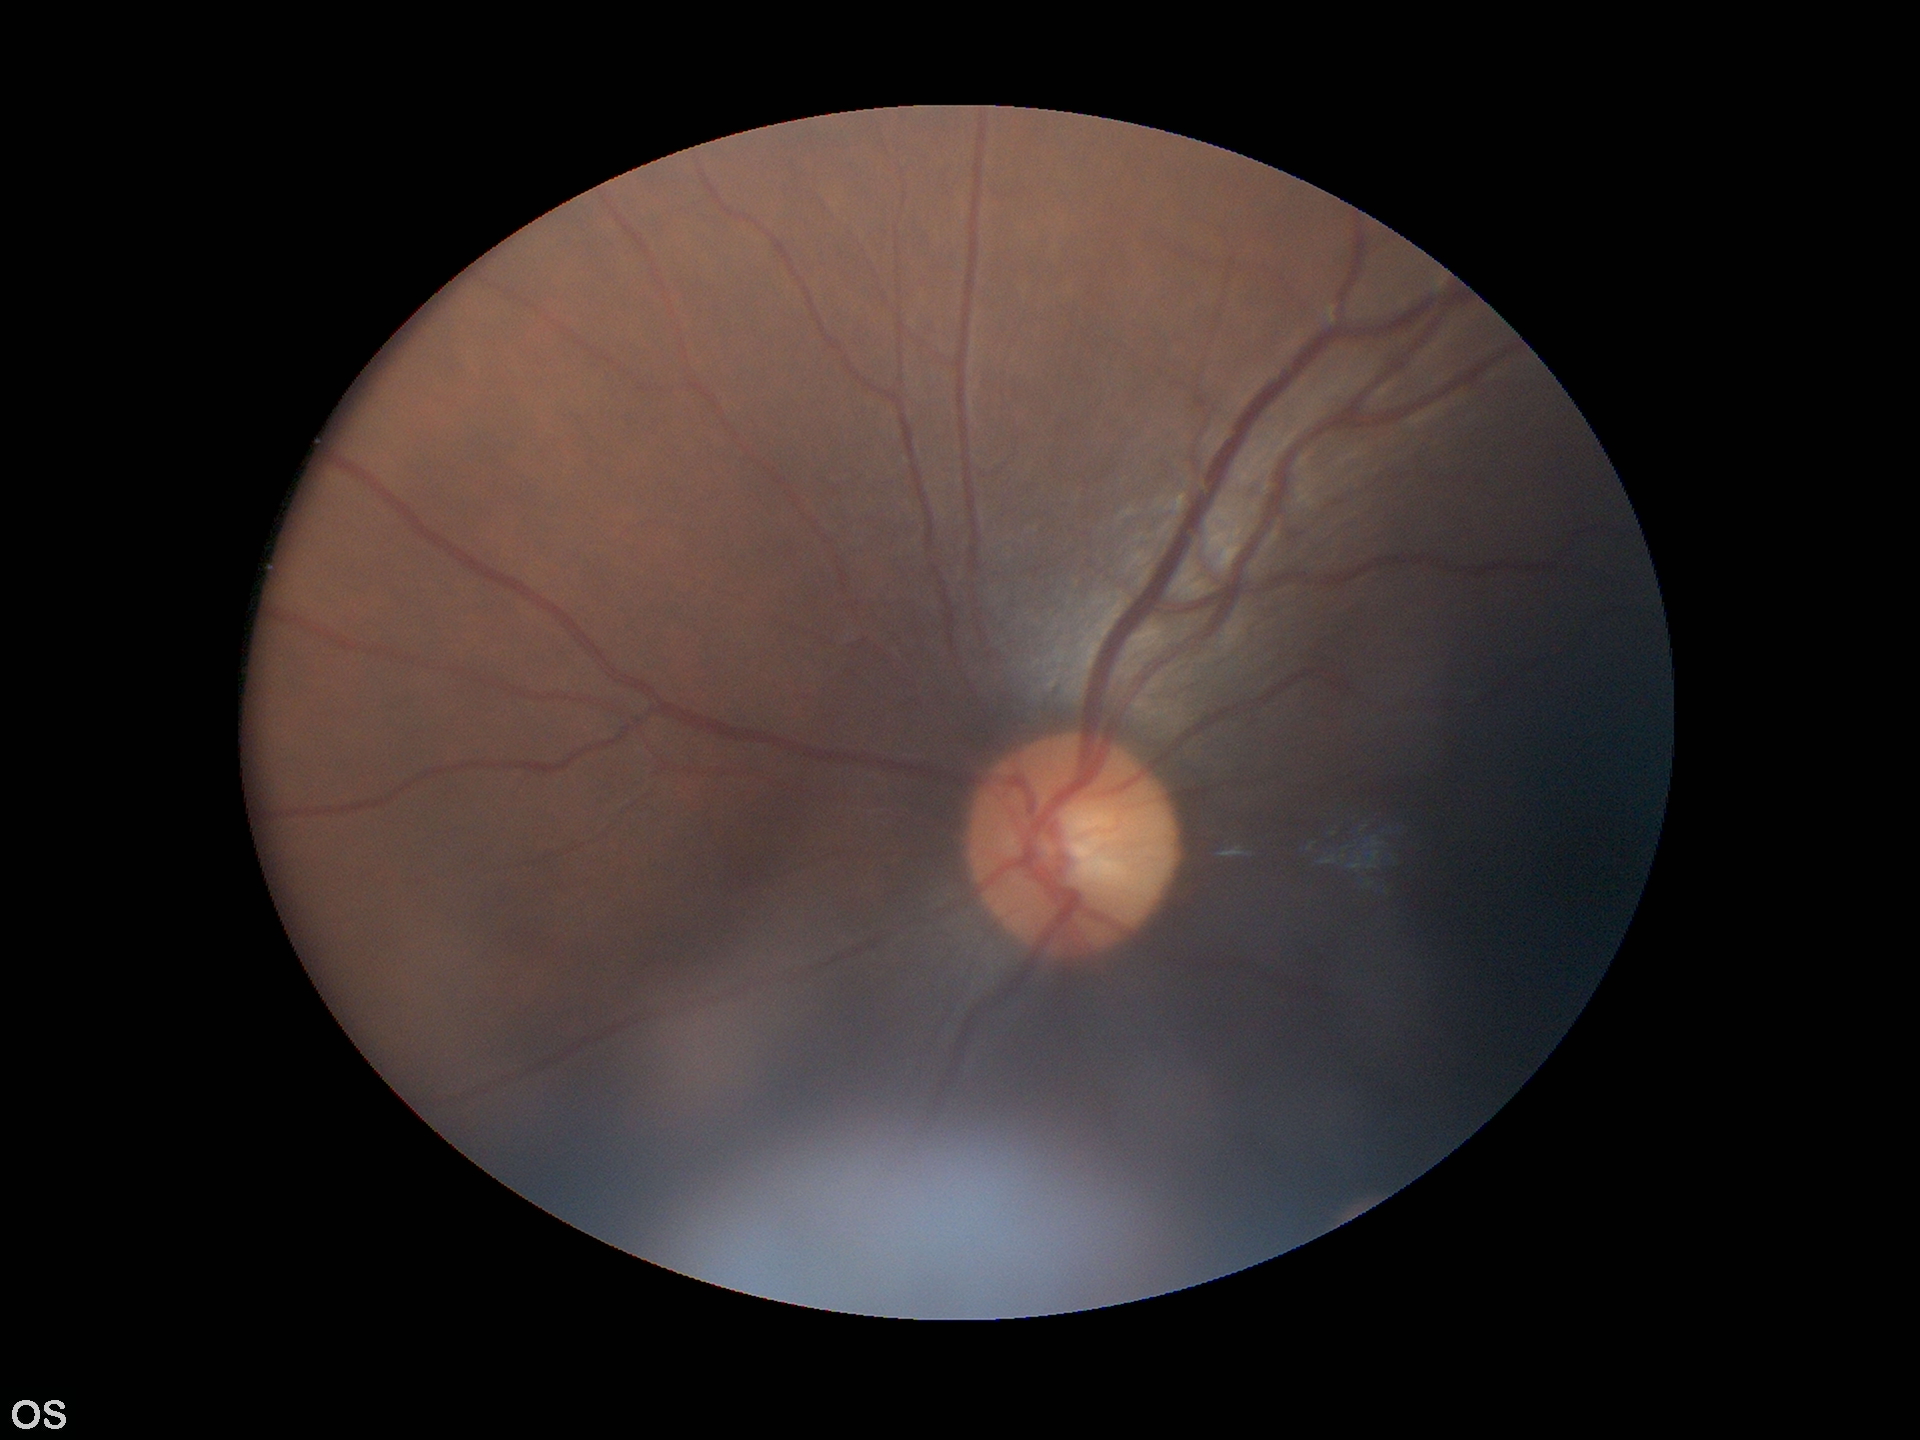

Glaucoma screening impression: no suspicious findings.
Vertical C/D ratio (VCDR): 0.49.